45° field of view · fundus photo · 412 x 310 pixels:
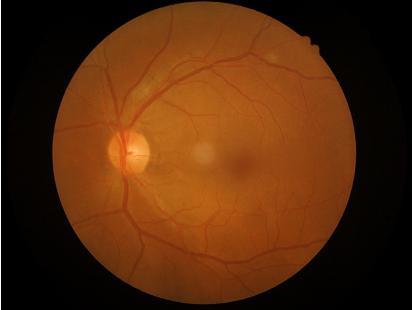

Focus: sharp throughout the field
Overall: good, gradable
Illumination/color: no over- or under-exposure